848 x 848 pixels · 45° FOV: 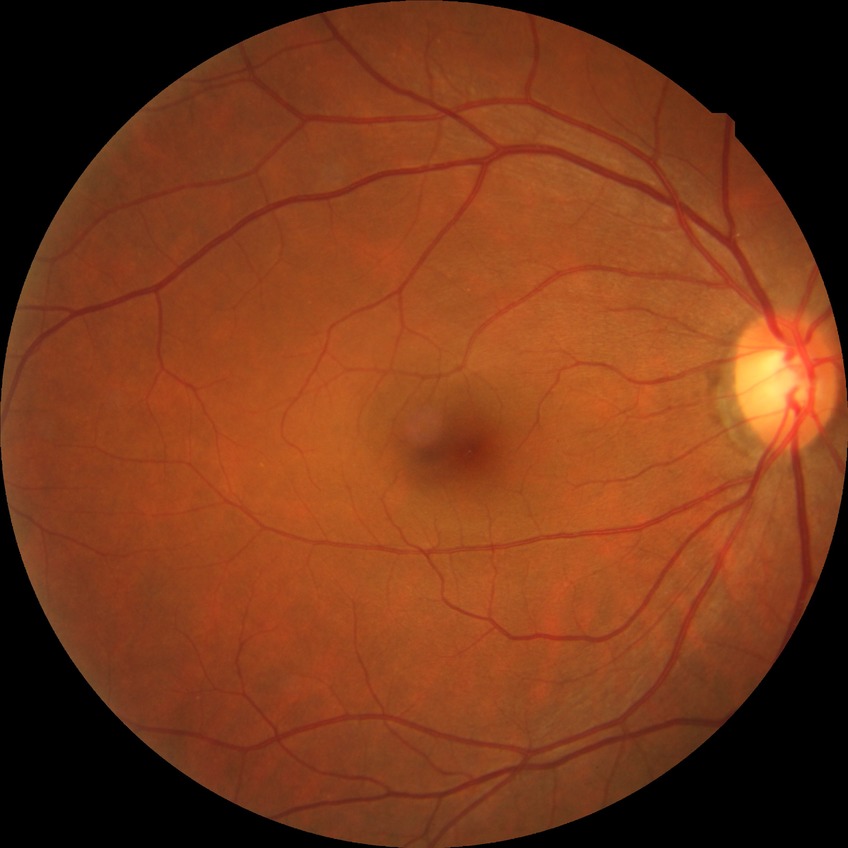
Davis grade is SDR.